Mydriatic (tropicamide 0.5%) — 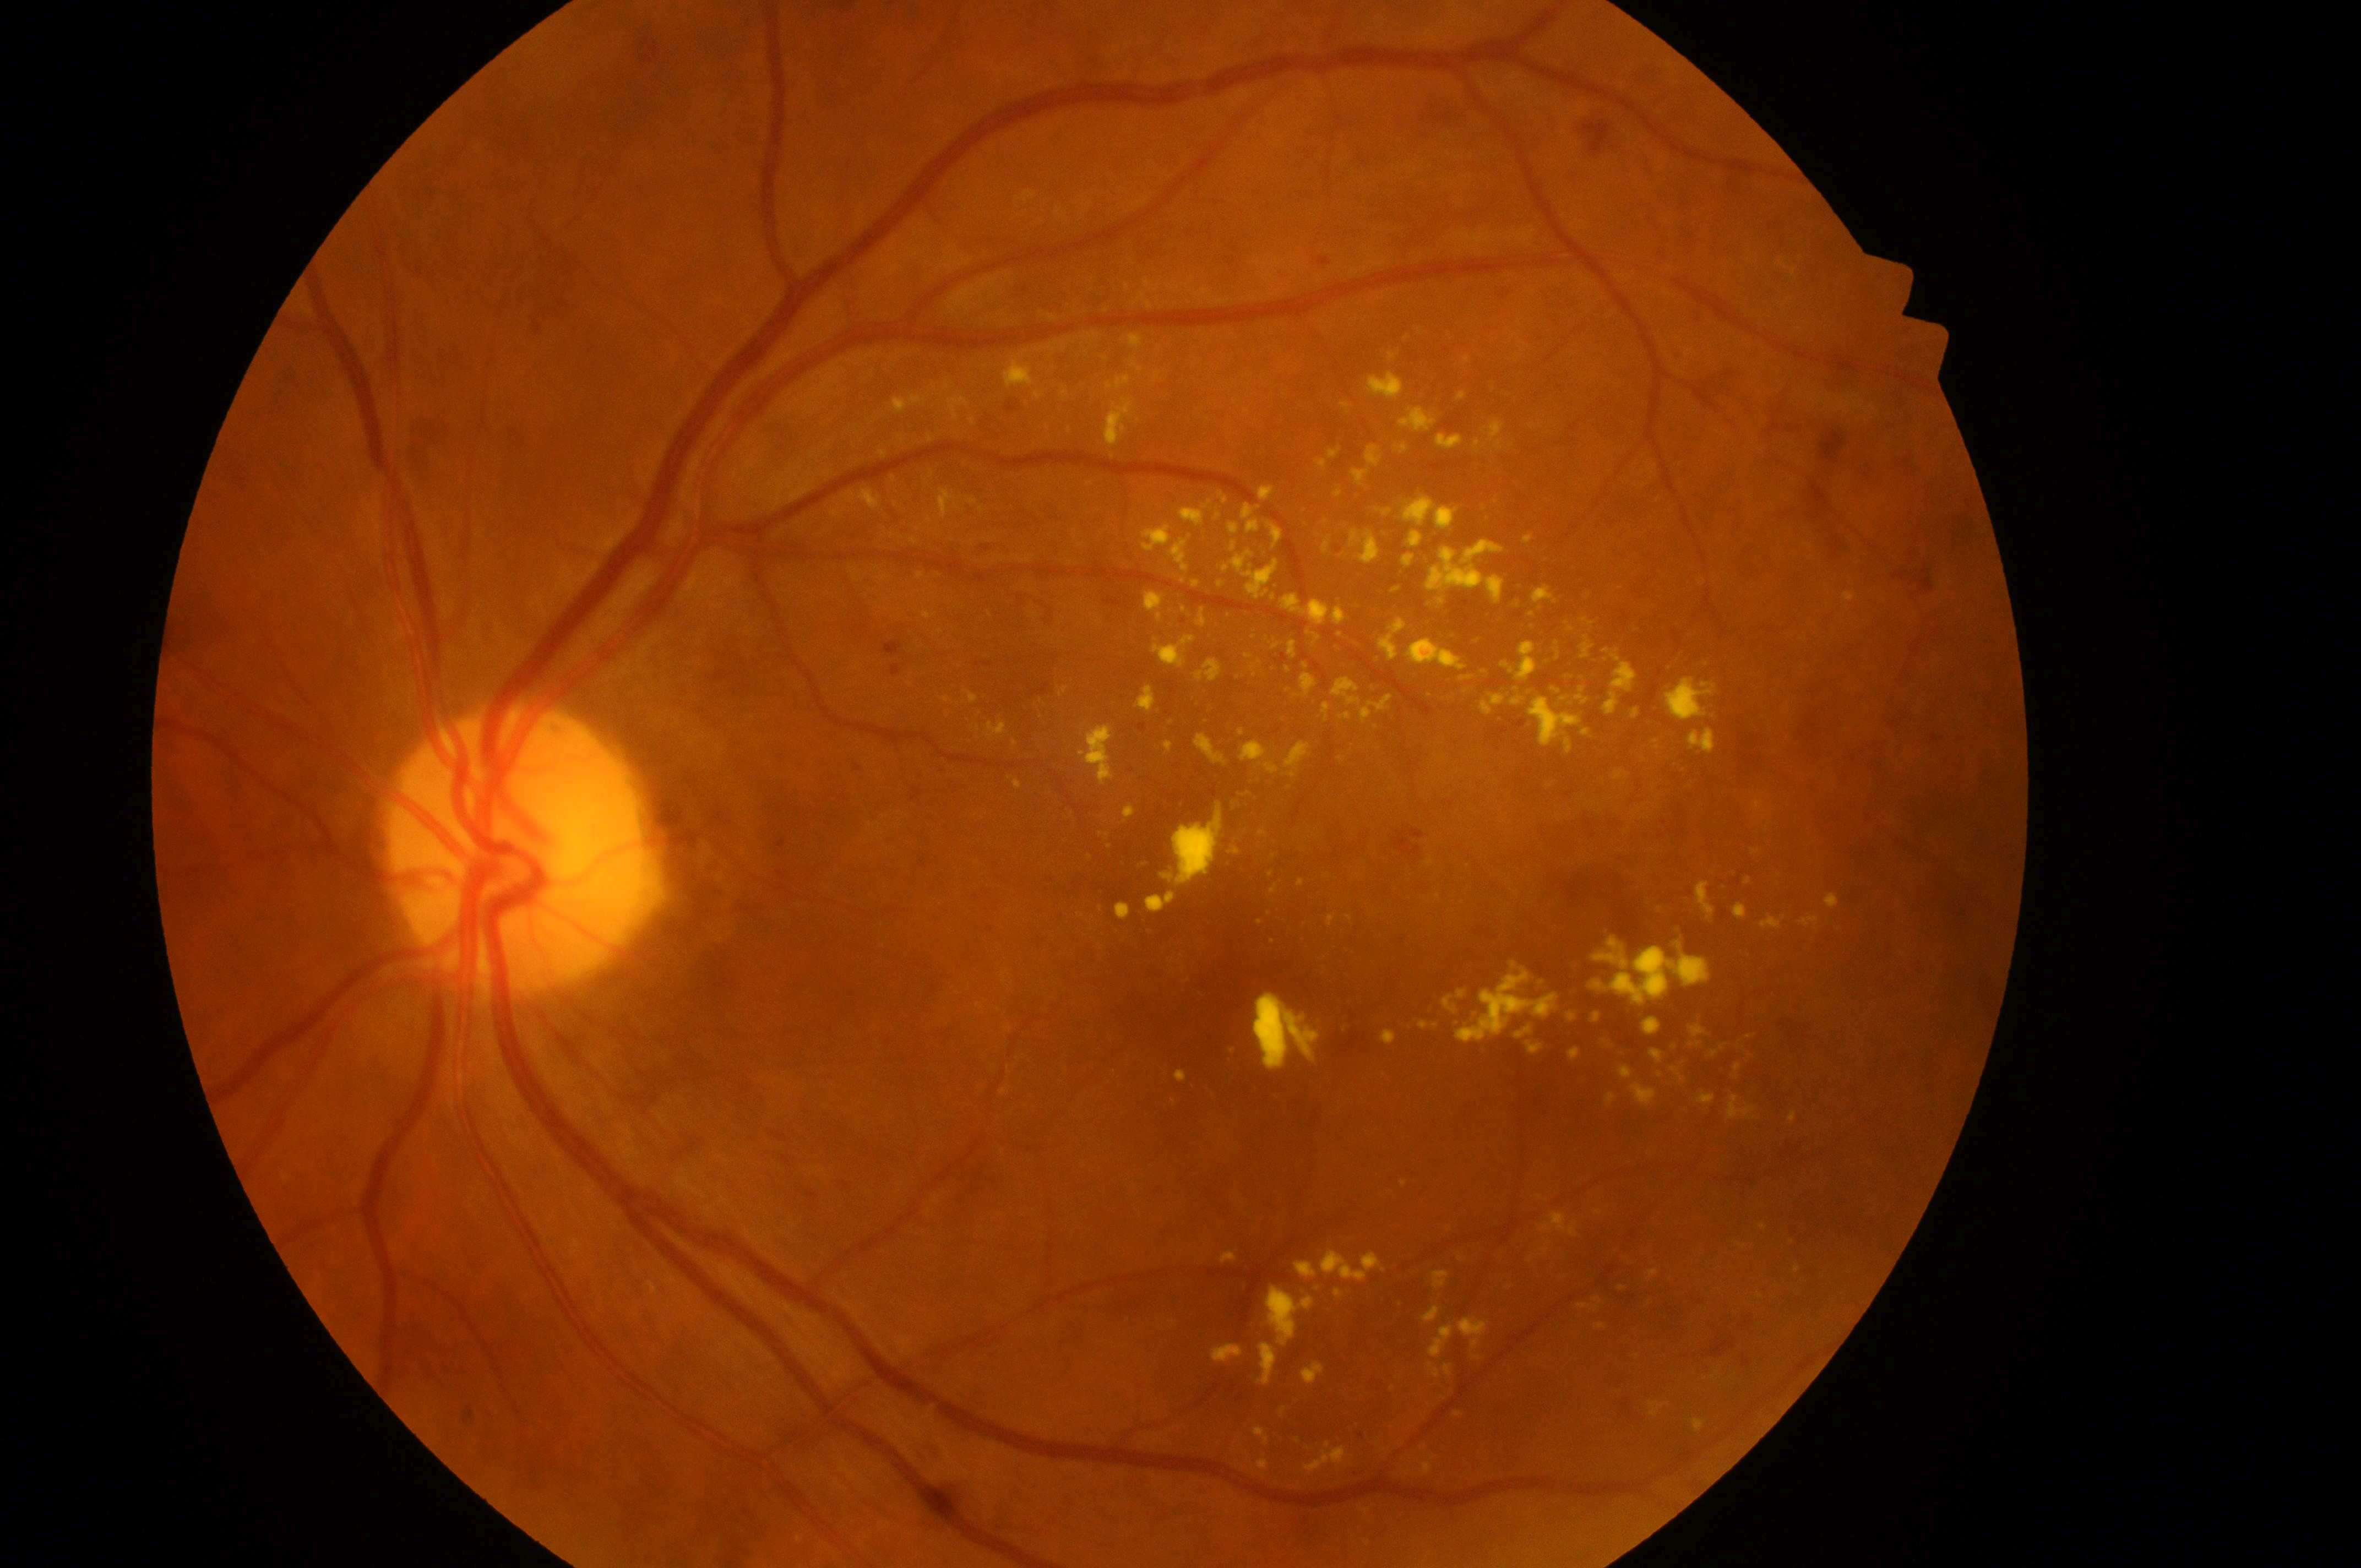

Optic disc: 509, 864.
Diabetic macular edema is grade 2.
Eye: left.
Foveal center: 1269, 1019.
Retinopathy grade is 2.